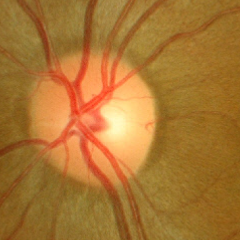
Optic nerve head appearance consistent with no glaucomatous optic neuropathy.